1932x1916: 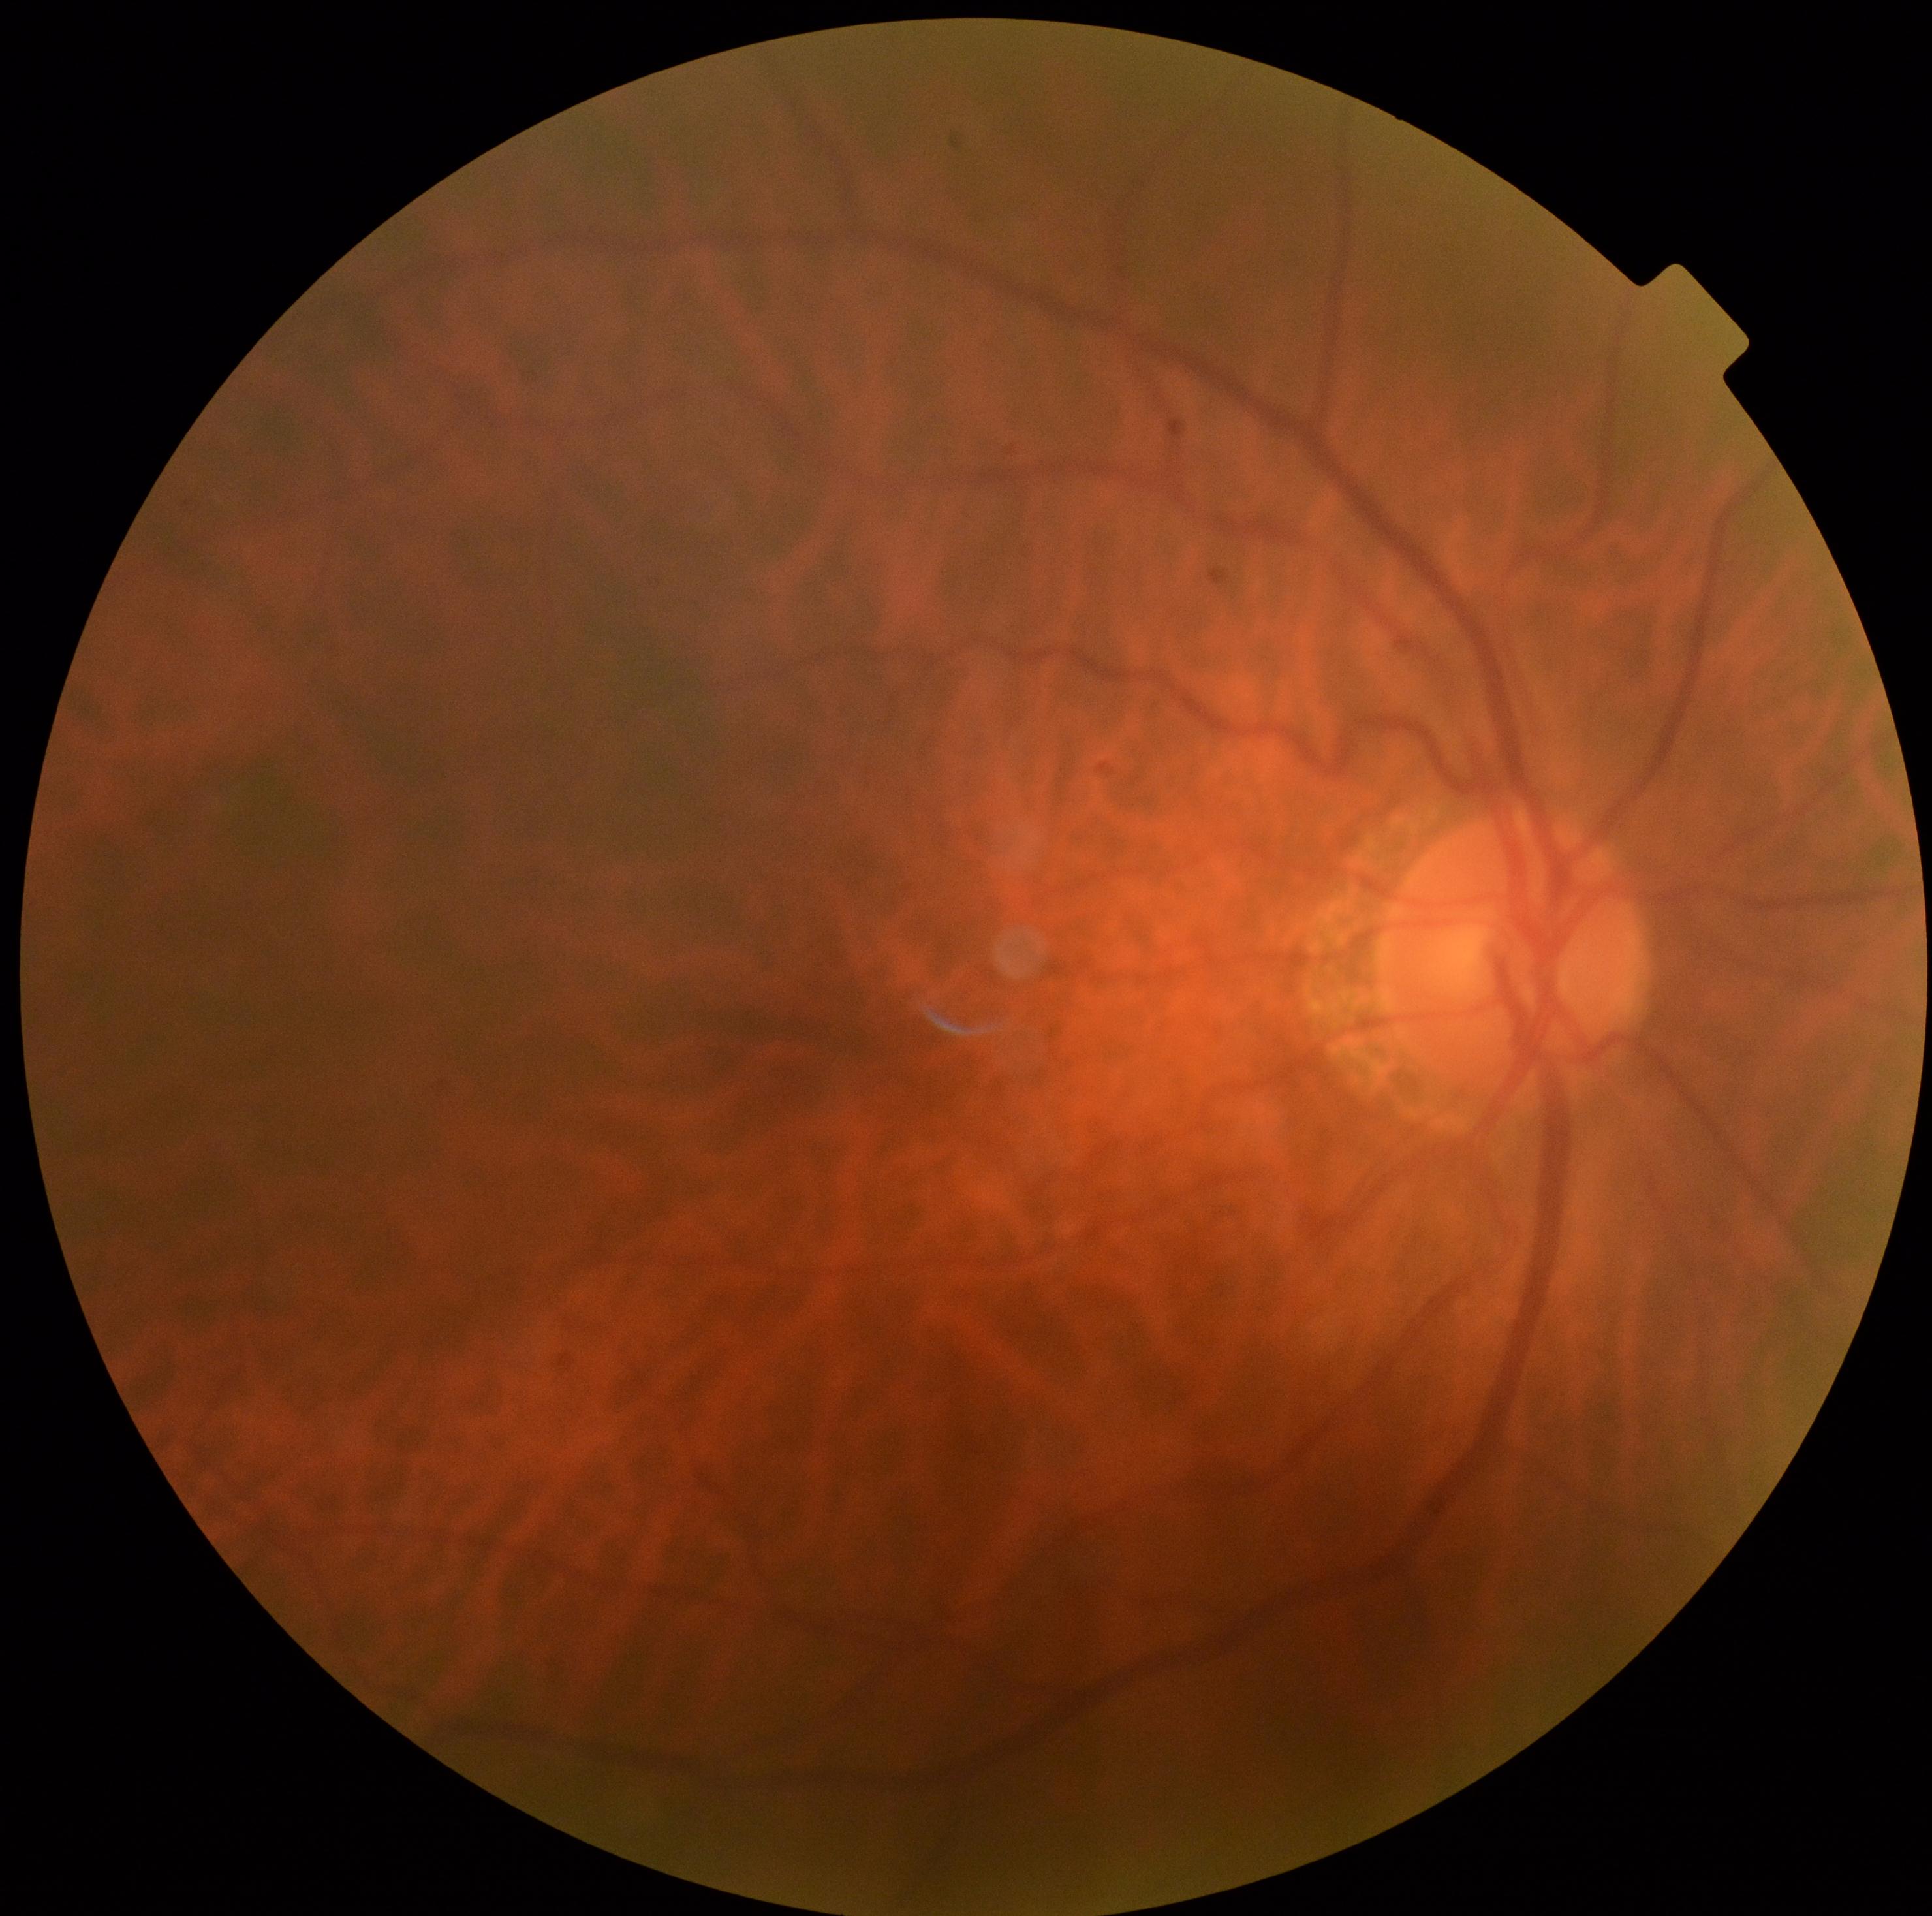
Retinopathy: no apparent retinopathy (grade 0) — no visible signs of diabetic retinopathy.